Visual field mean defect: -1.53 dB; intraocular pressure (IOP): 10 mmHg; axial length 25.77 mm; patient age: 74 years; 2212x1661px — 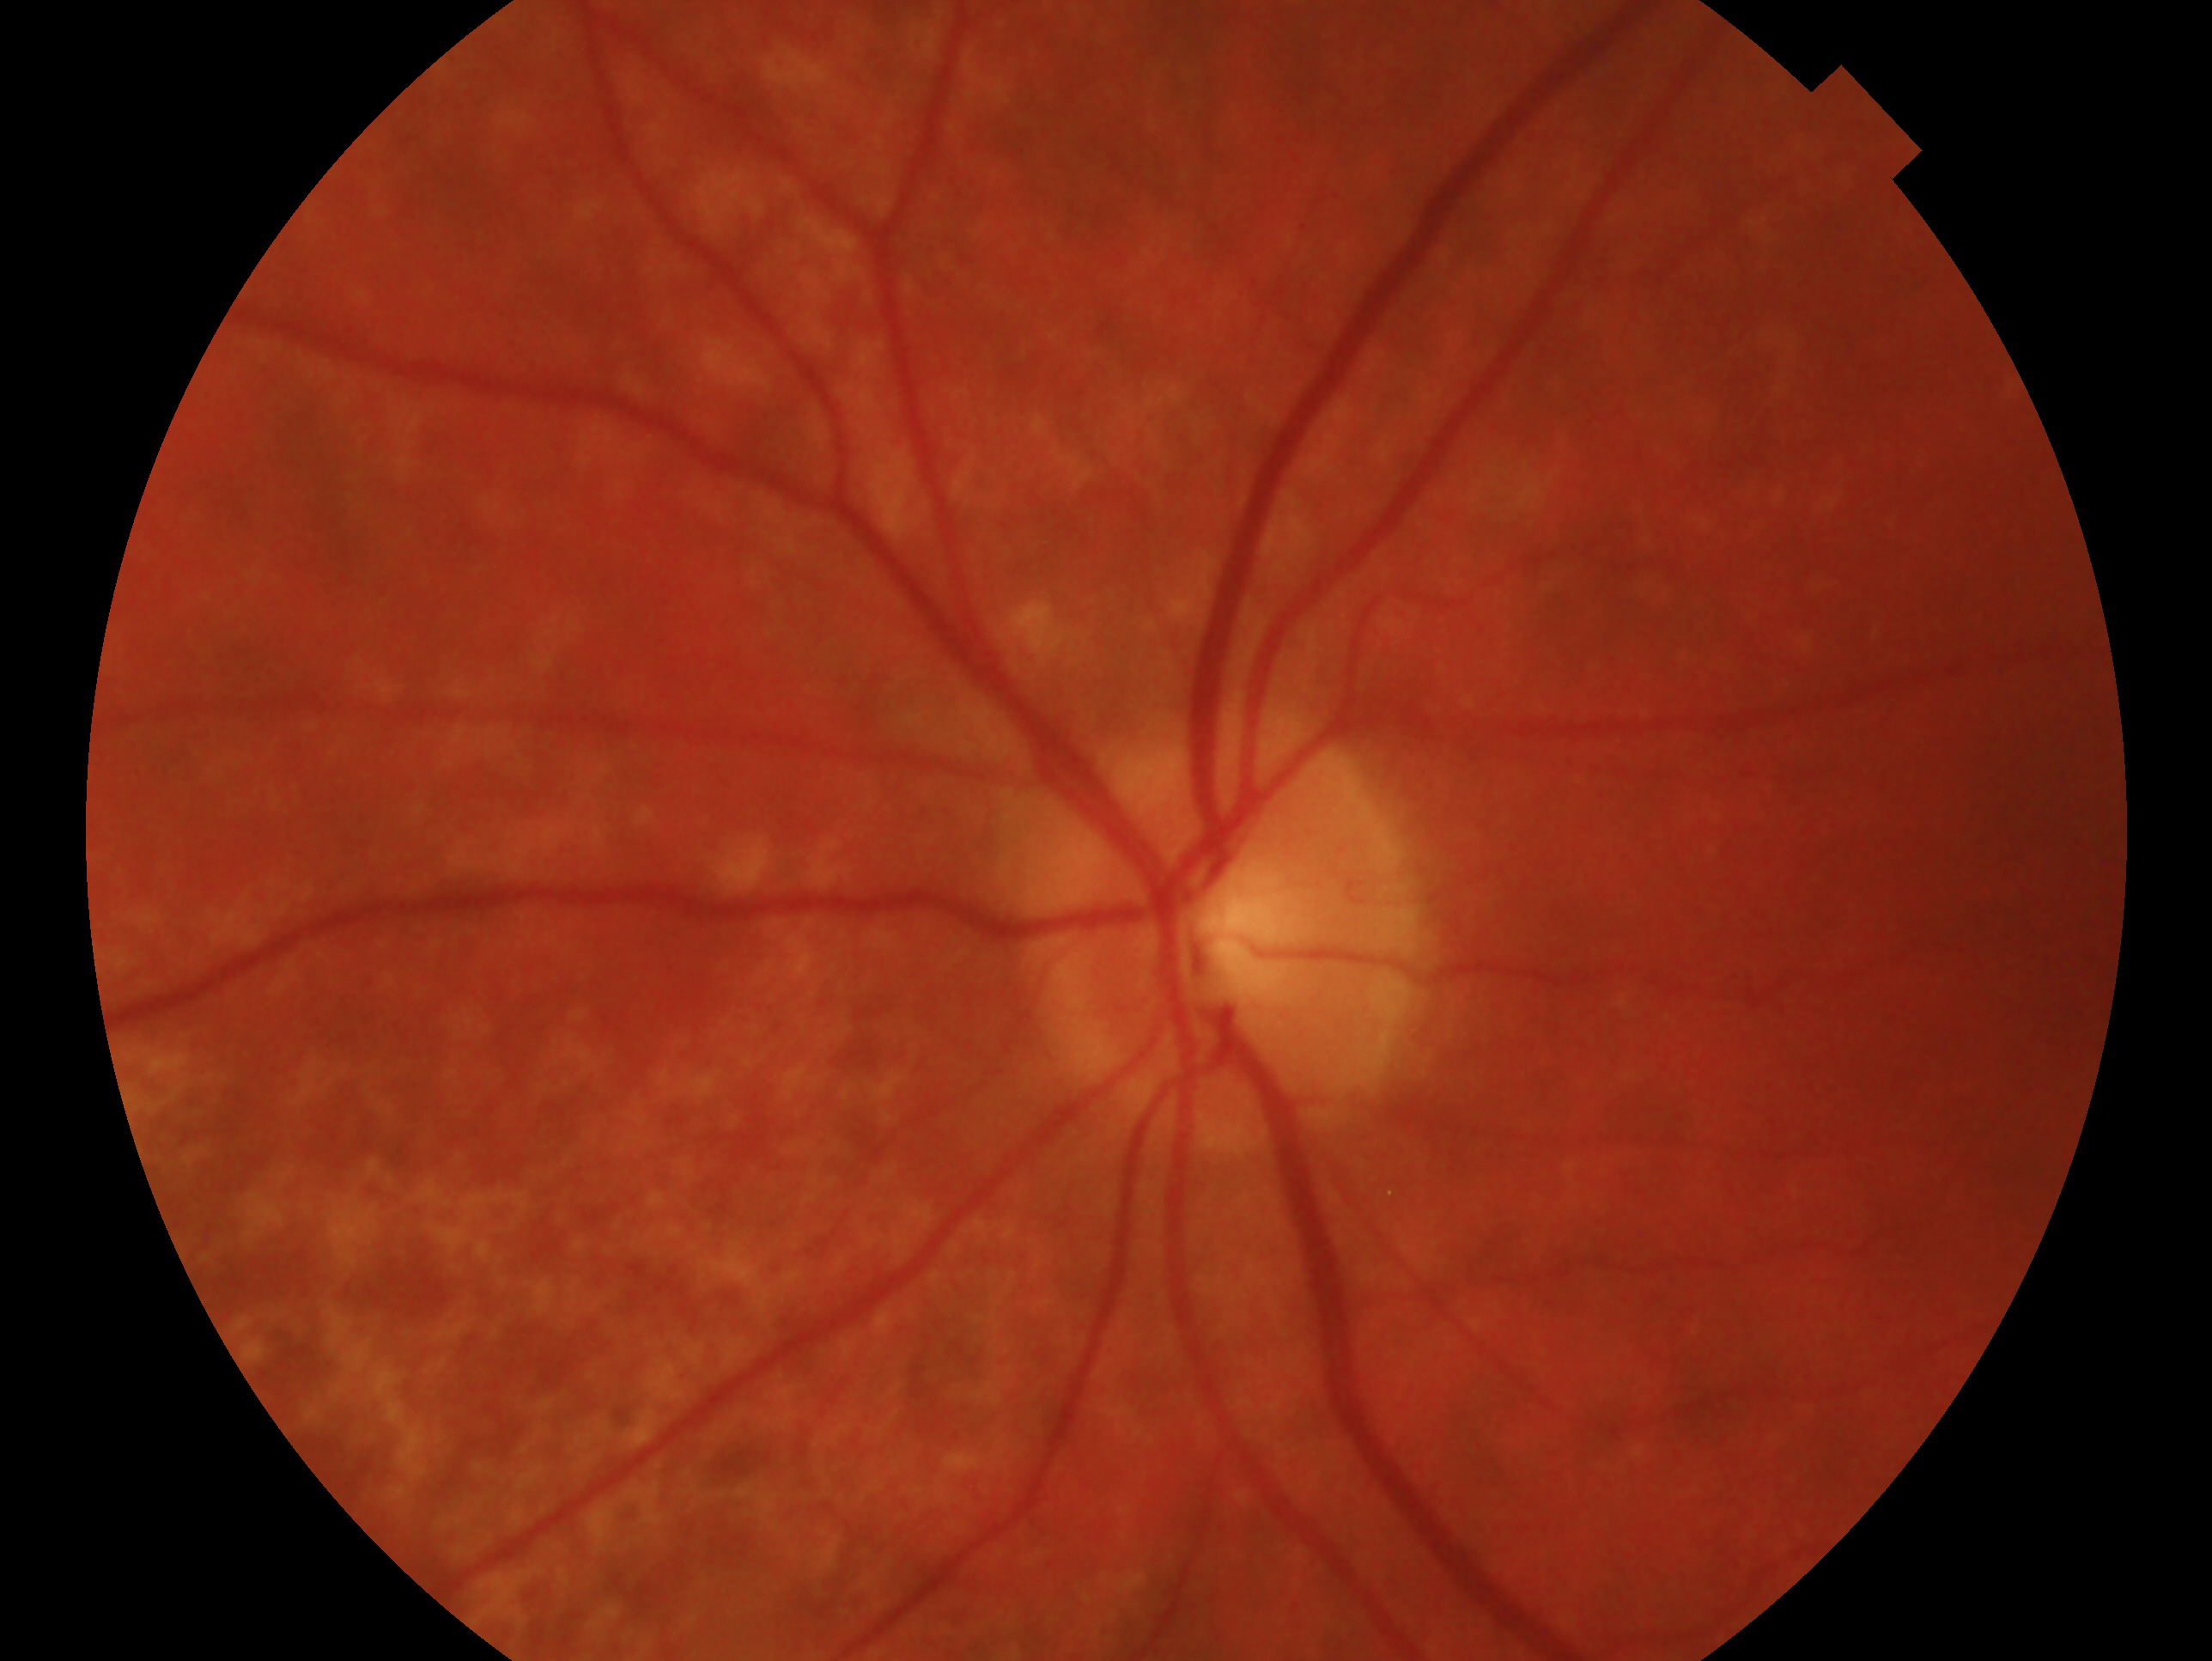

Glaucoma diagnosis: consistent with glaucoma. The image shows the oculus sinister.